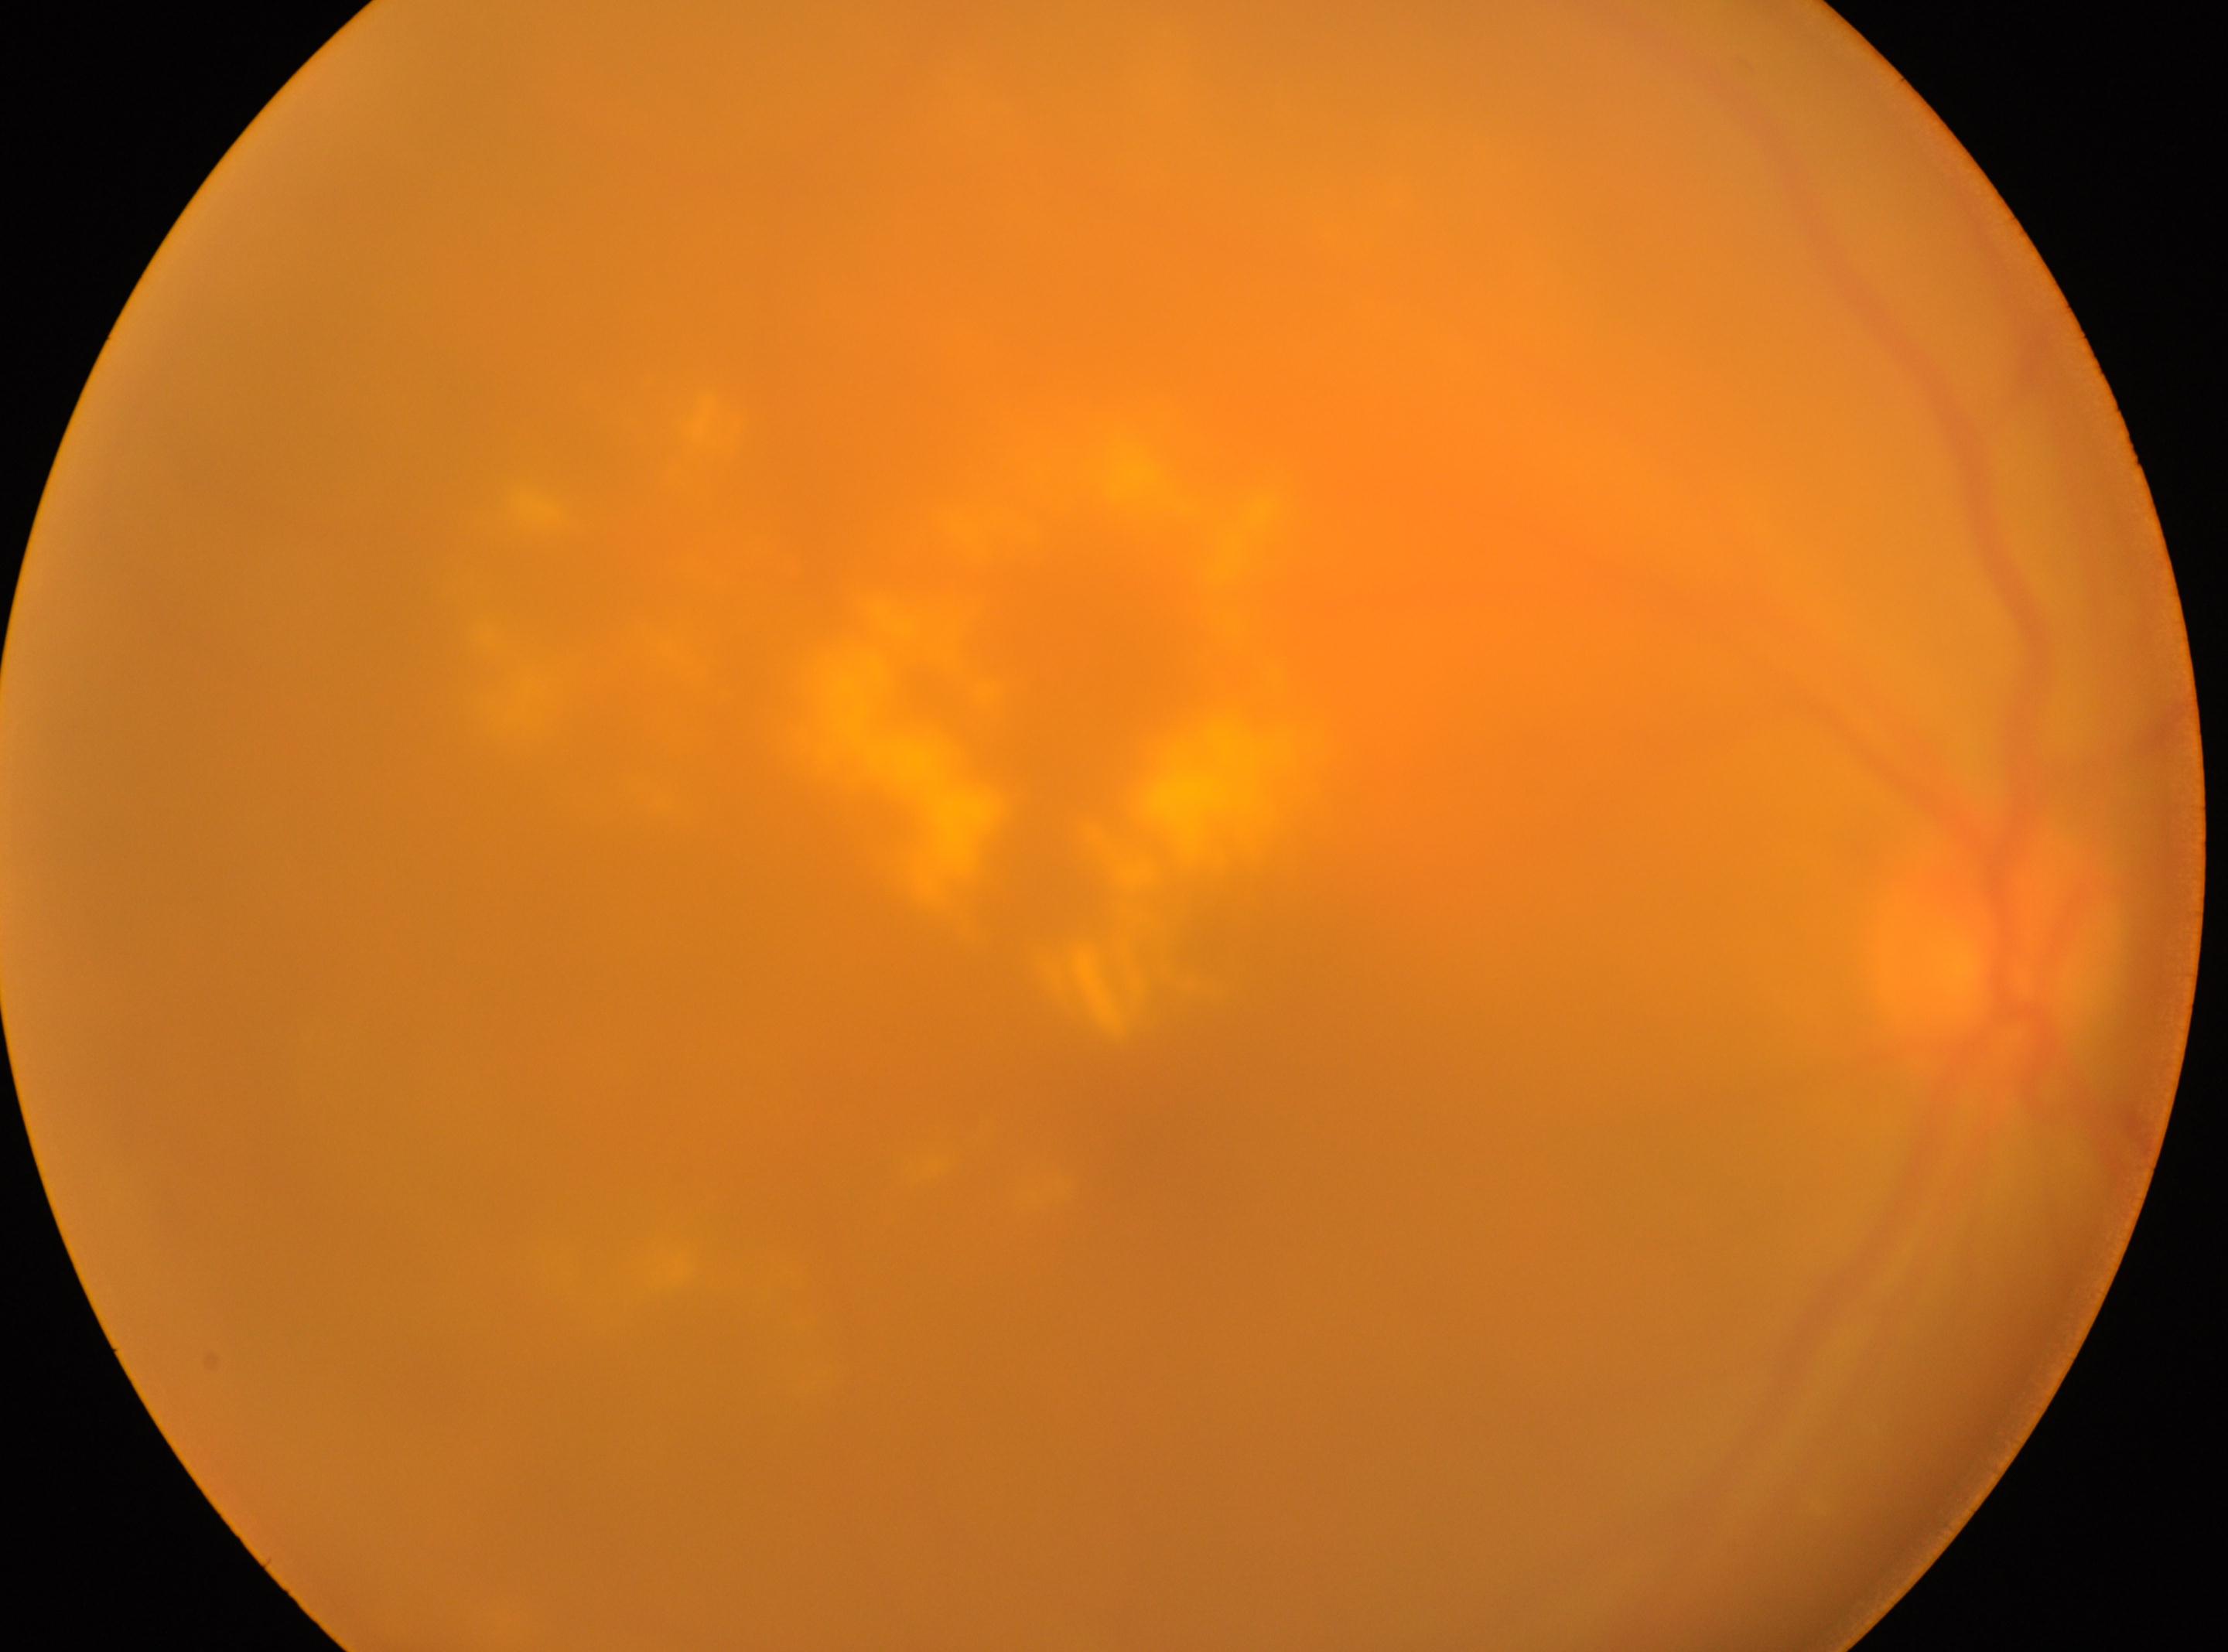
{"eye": "the right eye", "dr_grade": "moderate non-proliferative diabetic retinopathy (grade 2)", "optic_disc": "1999px, 957px", "fovea": "1150px, 1066px"}